Ultra-widefield fundus photograph:
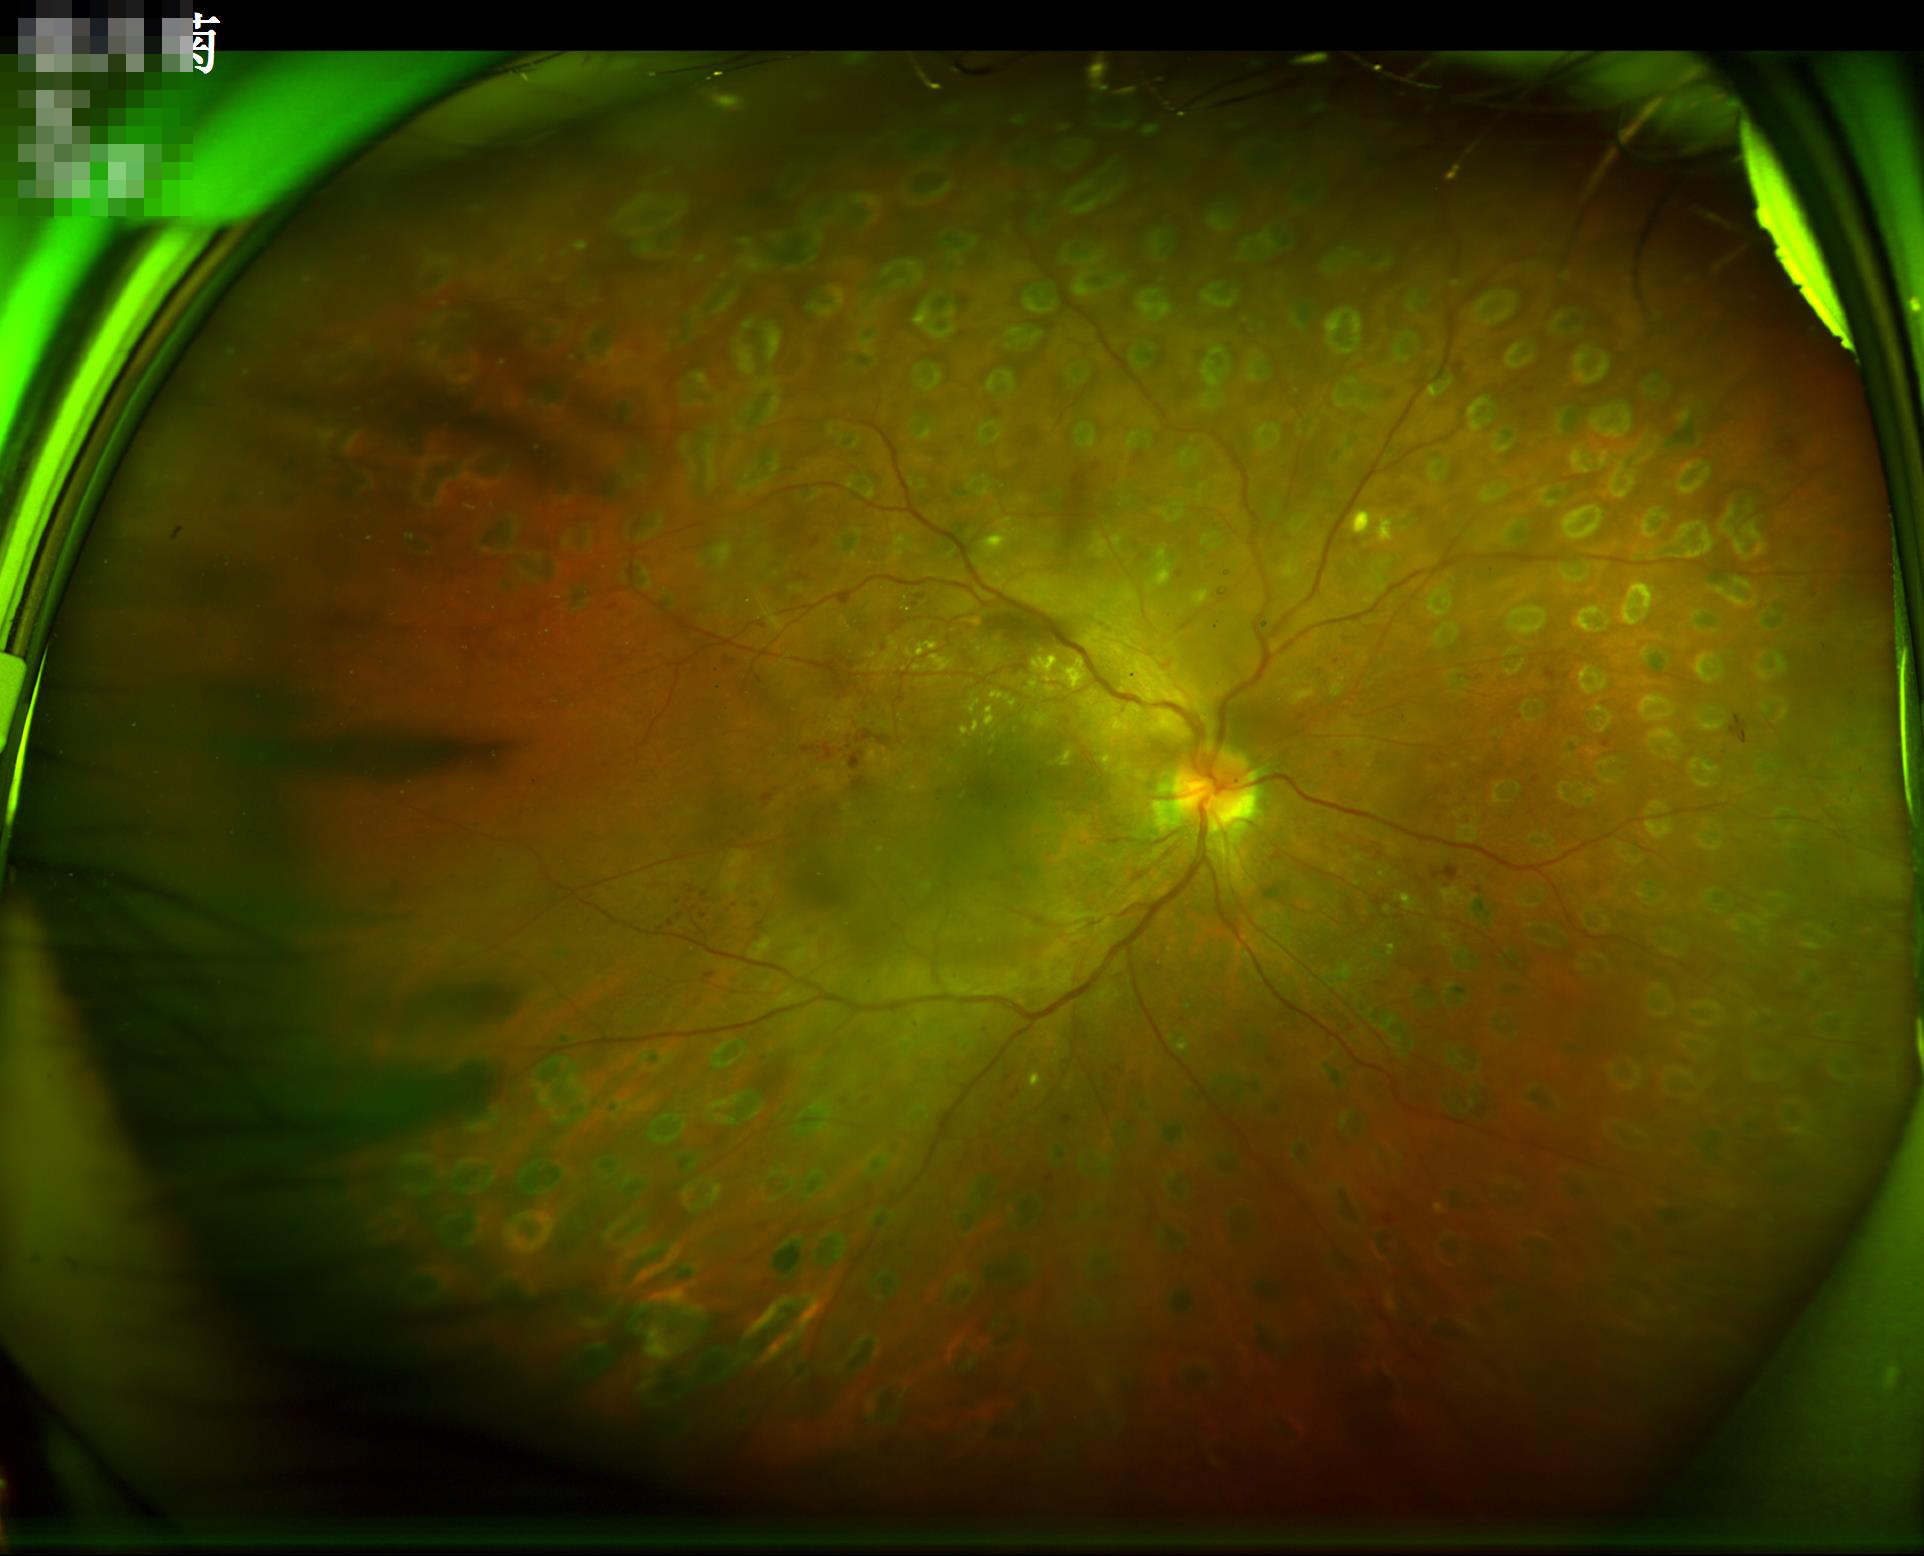
Poor illumination with uneven exposure.
The image is clear.
Acceptable image quality.
Vessels and details are readily distinguishable.